Nonmydriatic · FOV: 45 degrees · 848x848px: 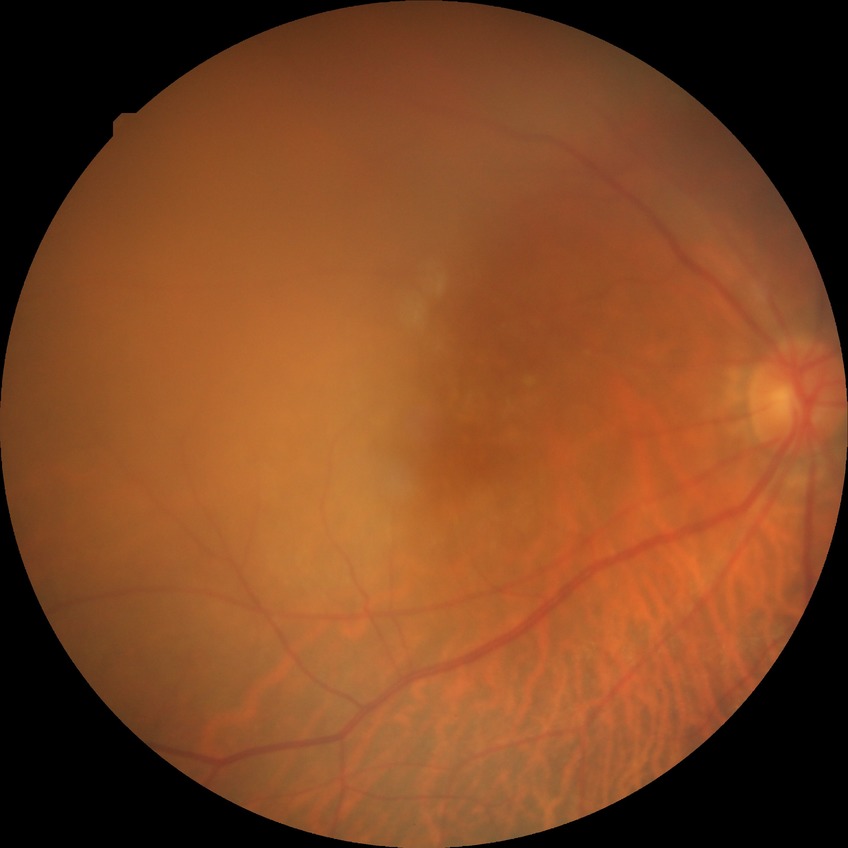 Diabetic retinopathy severity: no diabetic retinopathy.